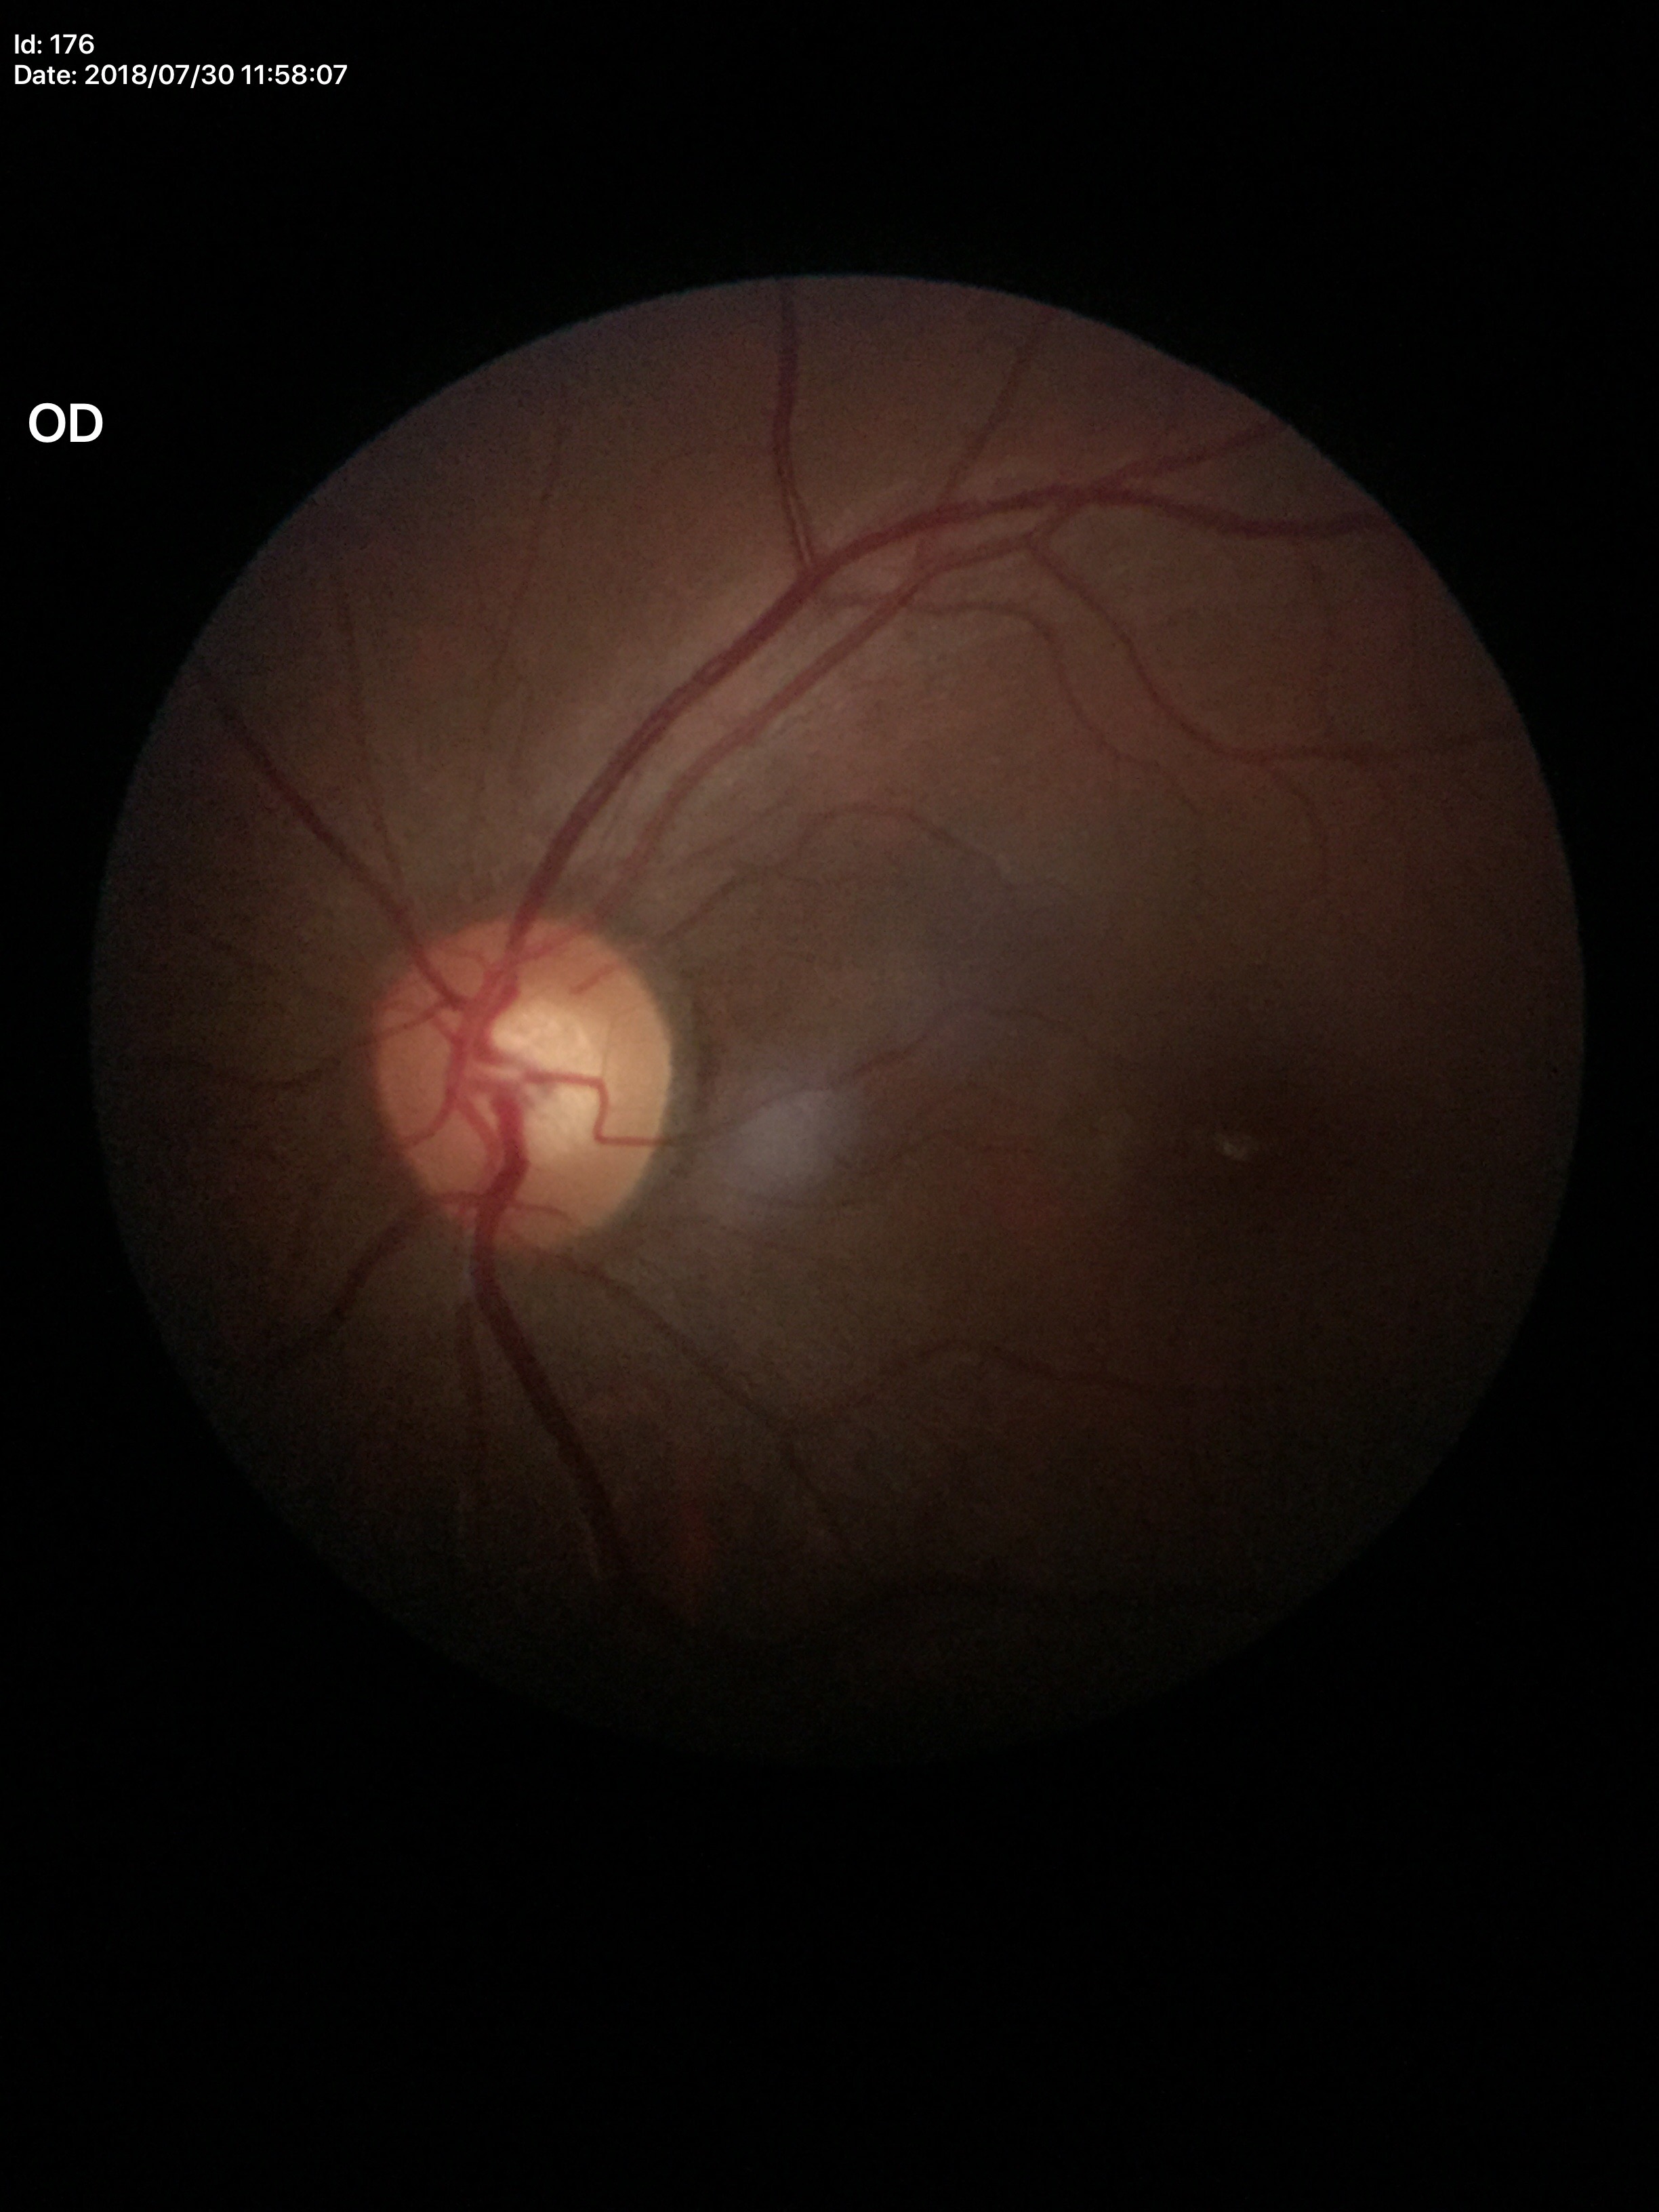
Negative for glaucoma suspicion.
Vertical cup-to-disc ratio: 0.57.